Retinal fundus photograph
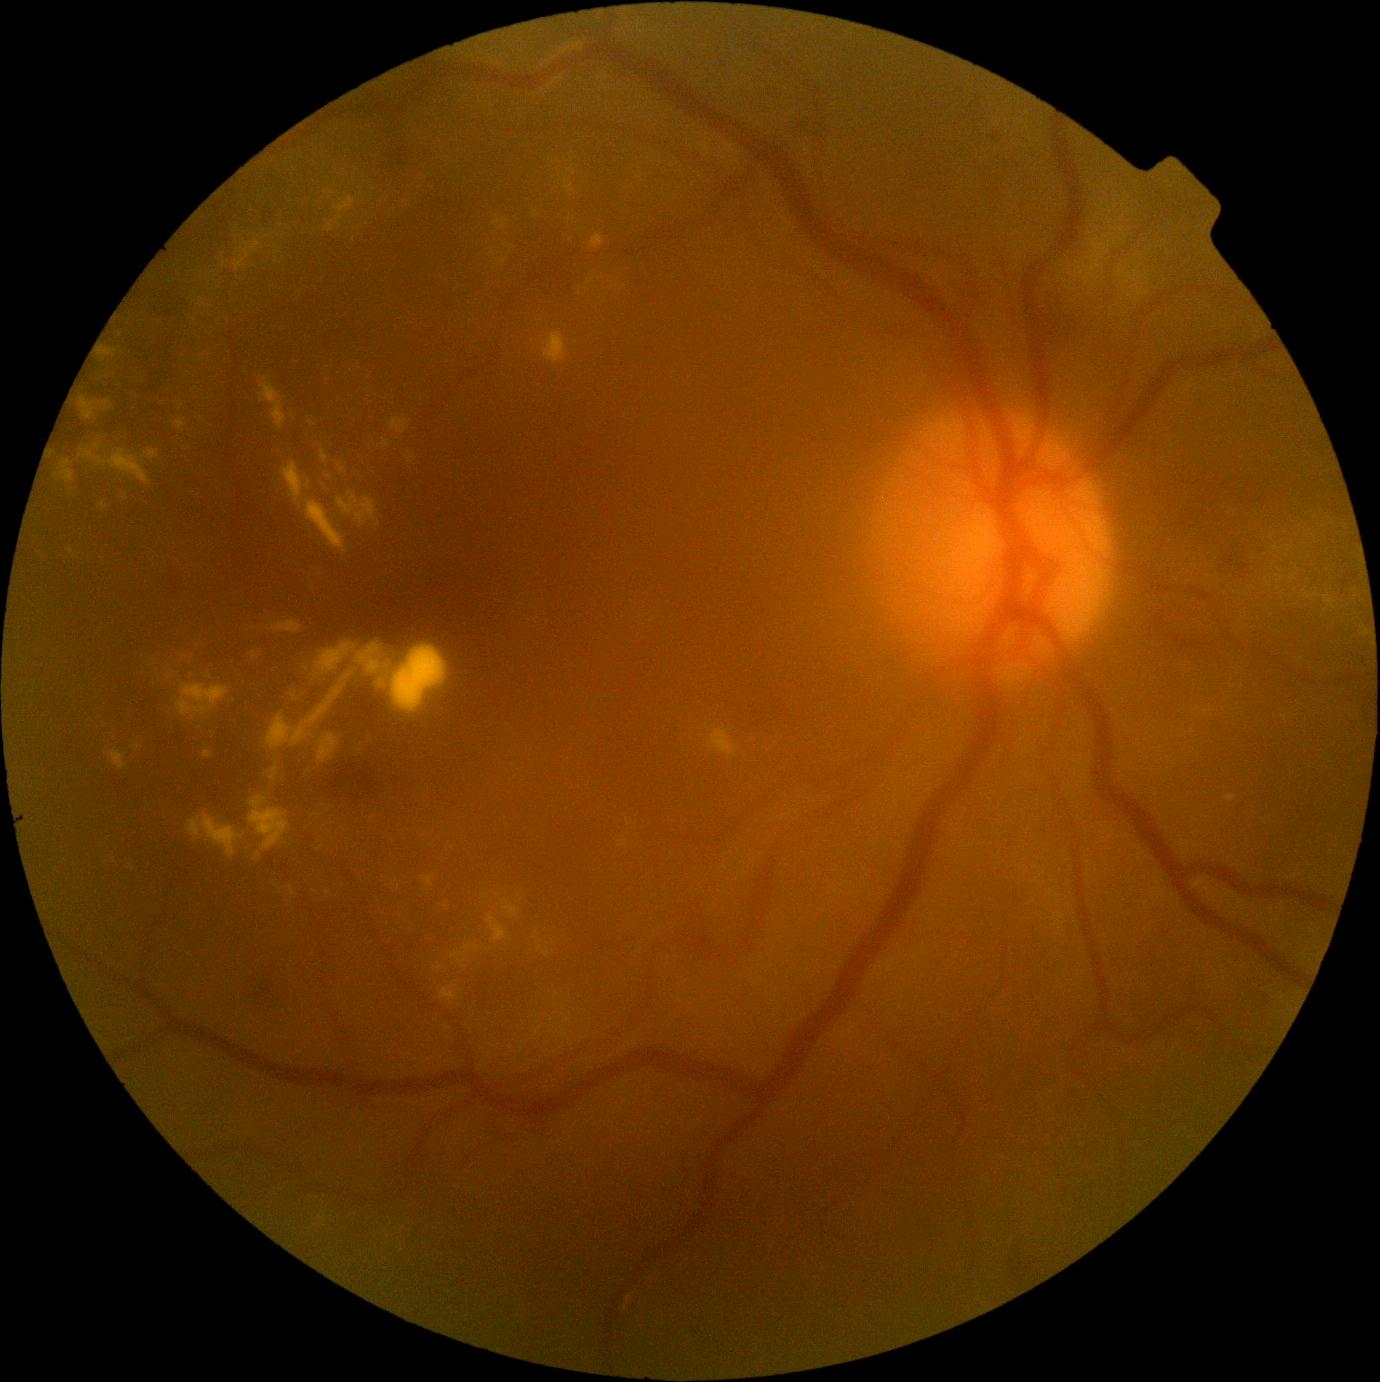

Diabetic retinopathy (DR) is moderate non-proliferative diabetic retinopathy (grade 2). Hard exudates (EXs) include lesions at (317, 734, 340, 767) | (1076, 268, 1084, 277) | (709, 729, 739, 760) | (590, 233, 606, 248) | (1132, 286, 1144, 297) | (109, 752, 127, 771) | (435, 966, 444, 971) | (249, 796, 289, 851) | (320, 450, 328, 462) | (777, 815, 786, 822) | (100, 347, 117, 357). Smaller EXs around Point(306, 668) | Point(359, 751) | Point(328, 893) | Point(126, 498) | Point(493, 253) | Point(1230, 513) | Point(601, 279).